Infant wide-field fundus photograph. Captured with the Phoenix ICON (100° field of view).
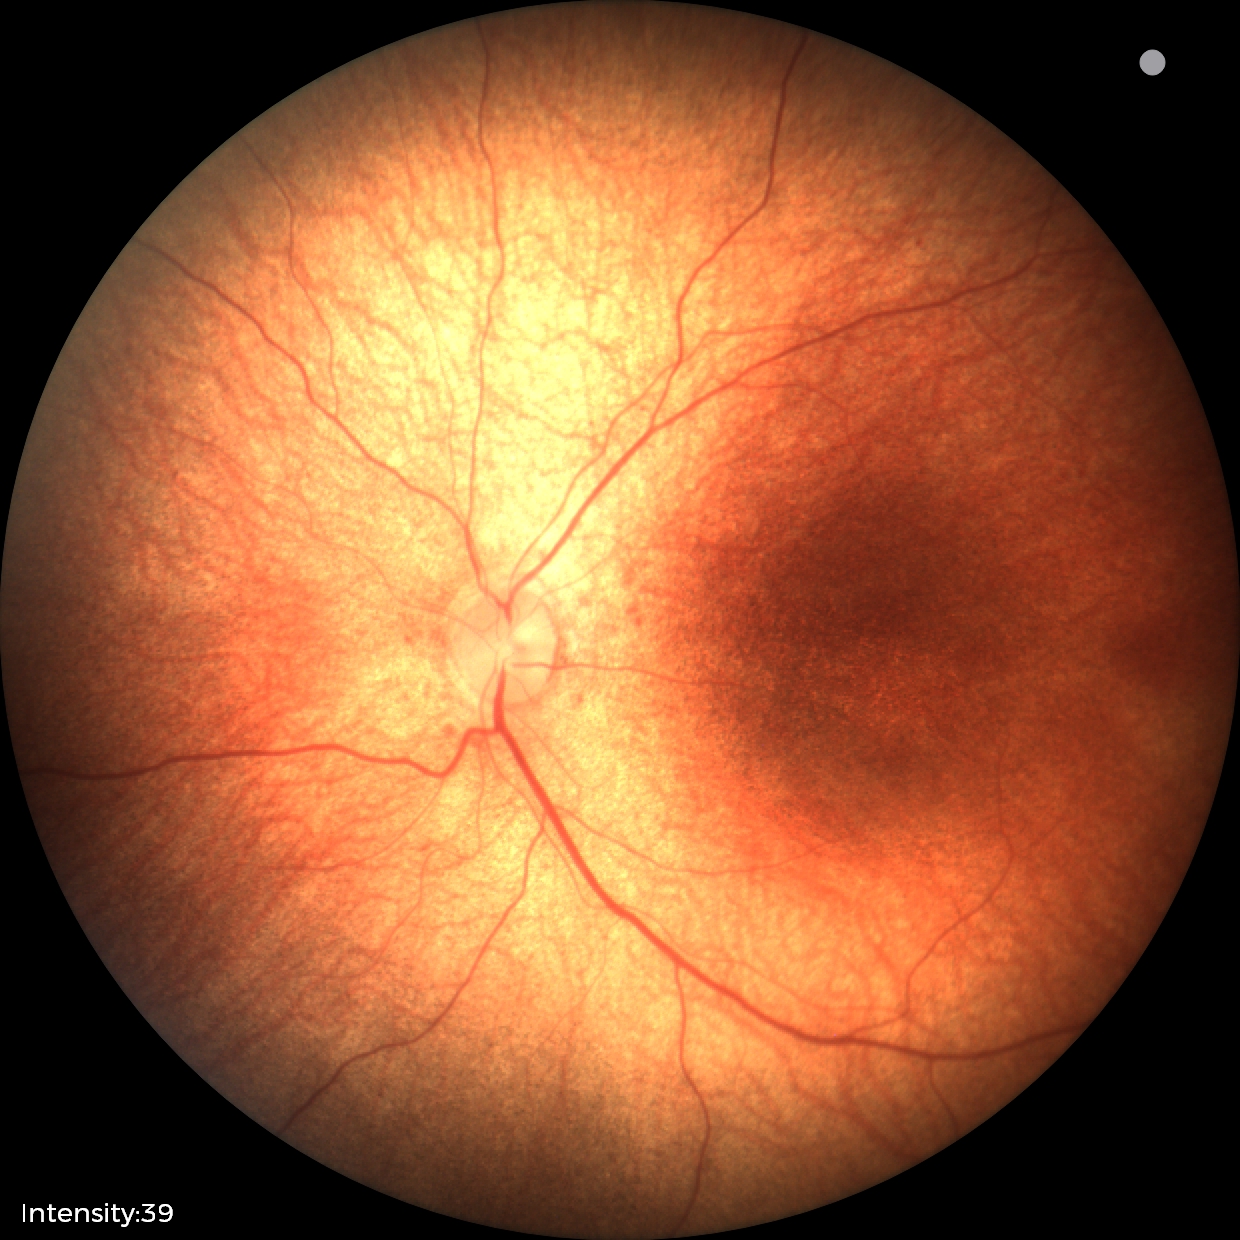
Normal screening examination.